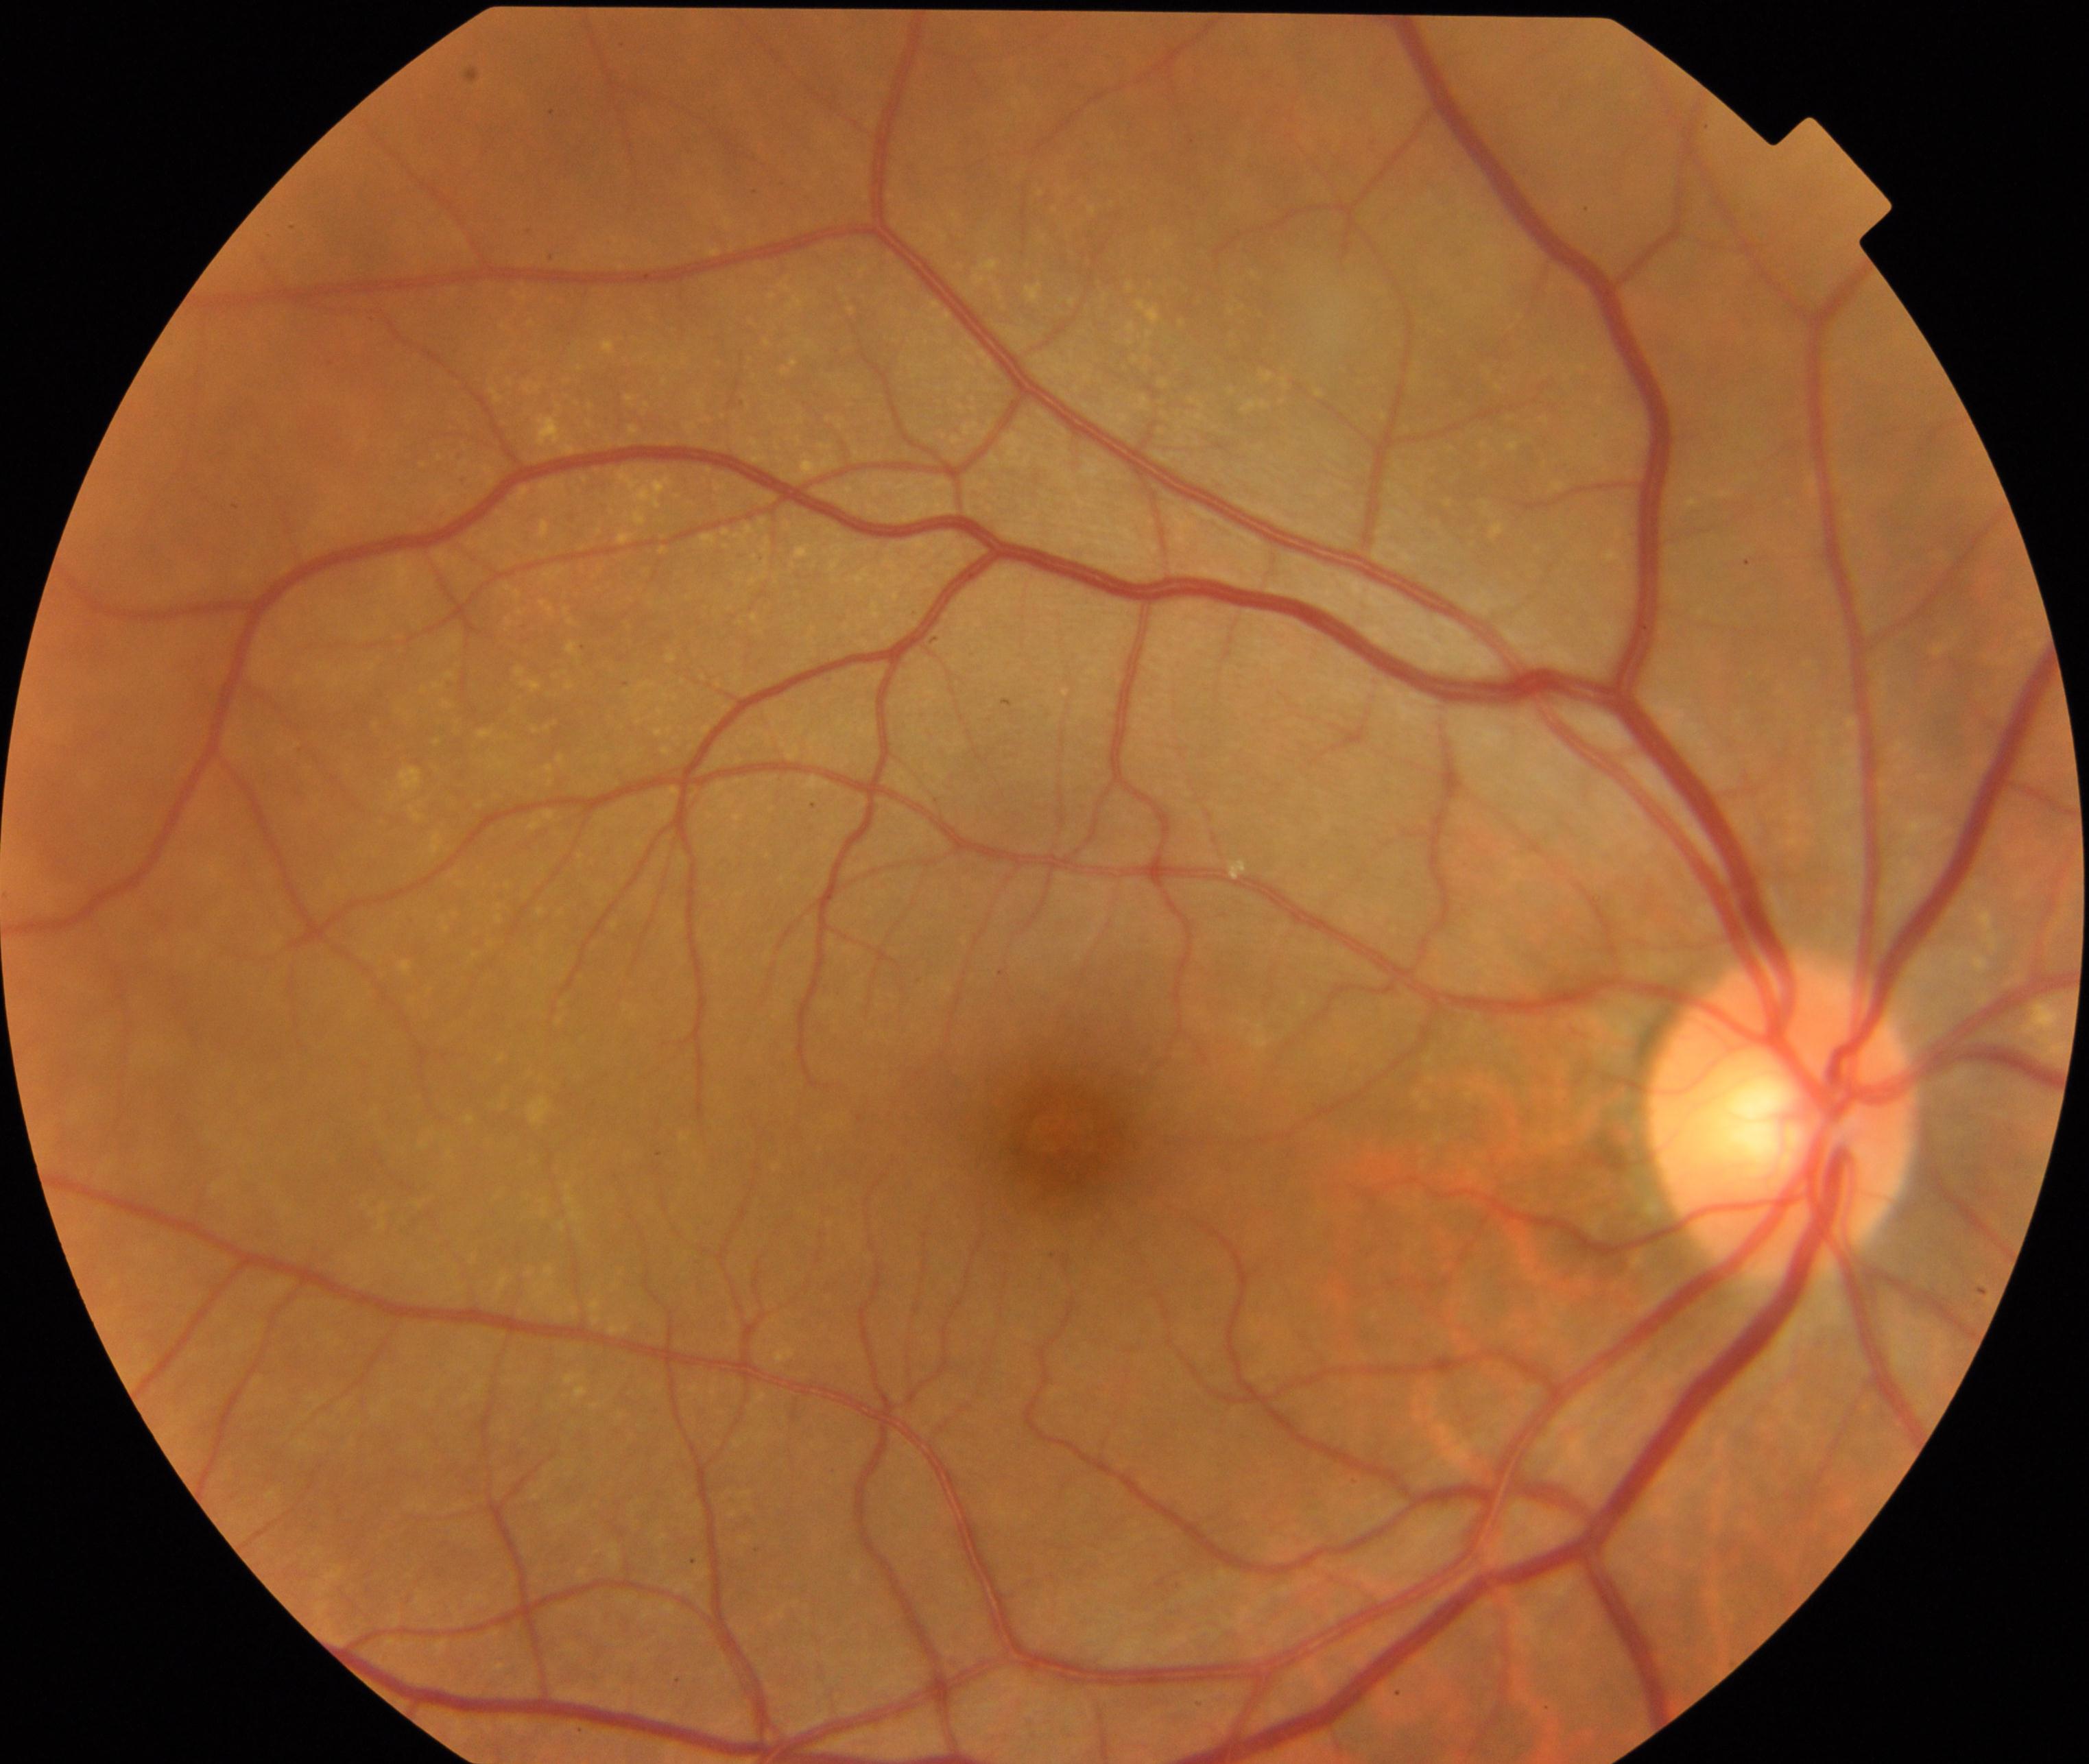

Fundus image consistent with yellow-white spots or flecks. Defined by multiple, discrete, yellow-white round dots or polymorphous fleck lesions, including early age-related macular degeneration (drusen <125 µm).